Phoenix ICON wide-field infant fundus image: 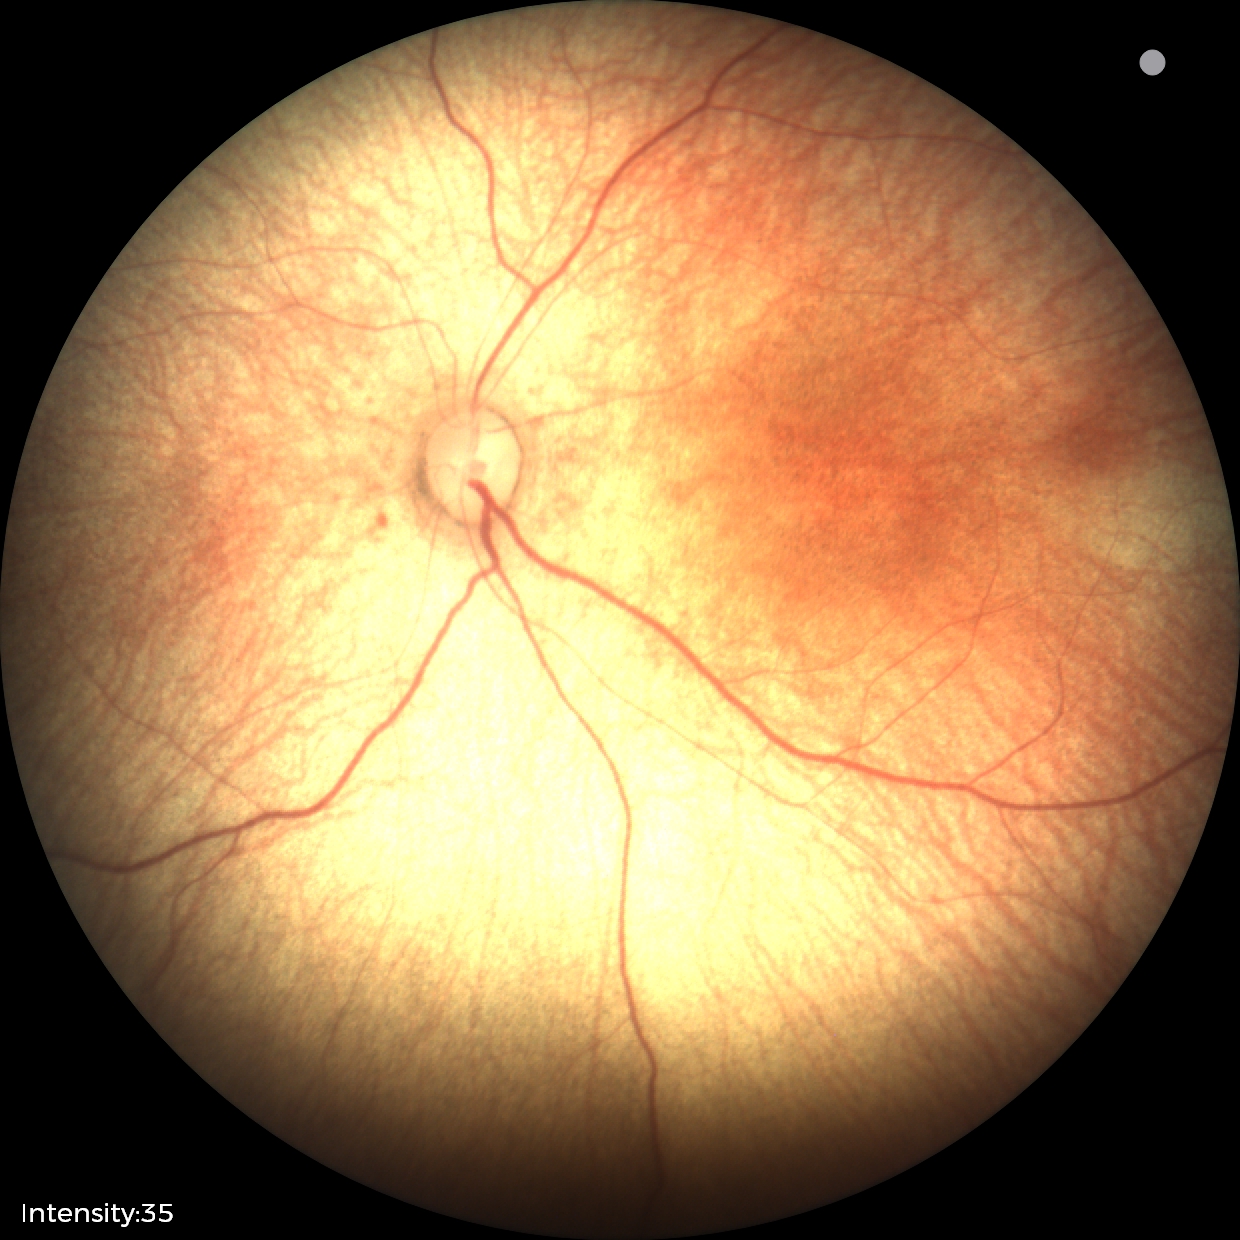

Normal screening examination.